Davis DR grading · nonmydriatic:
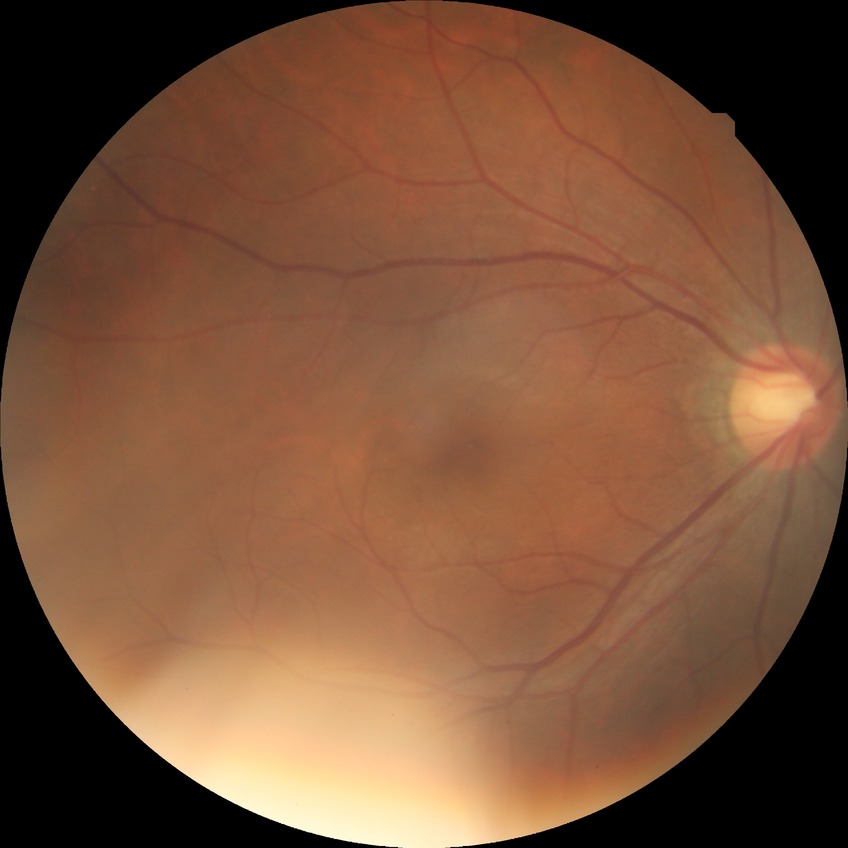

  davis_grade: NDR (no diabetic retinopathy)